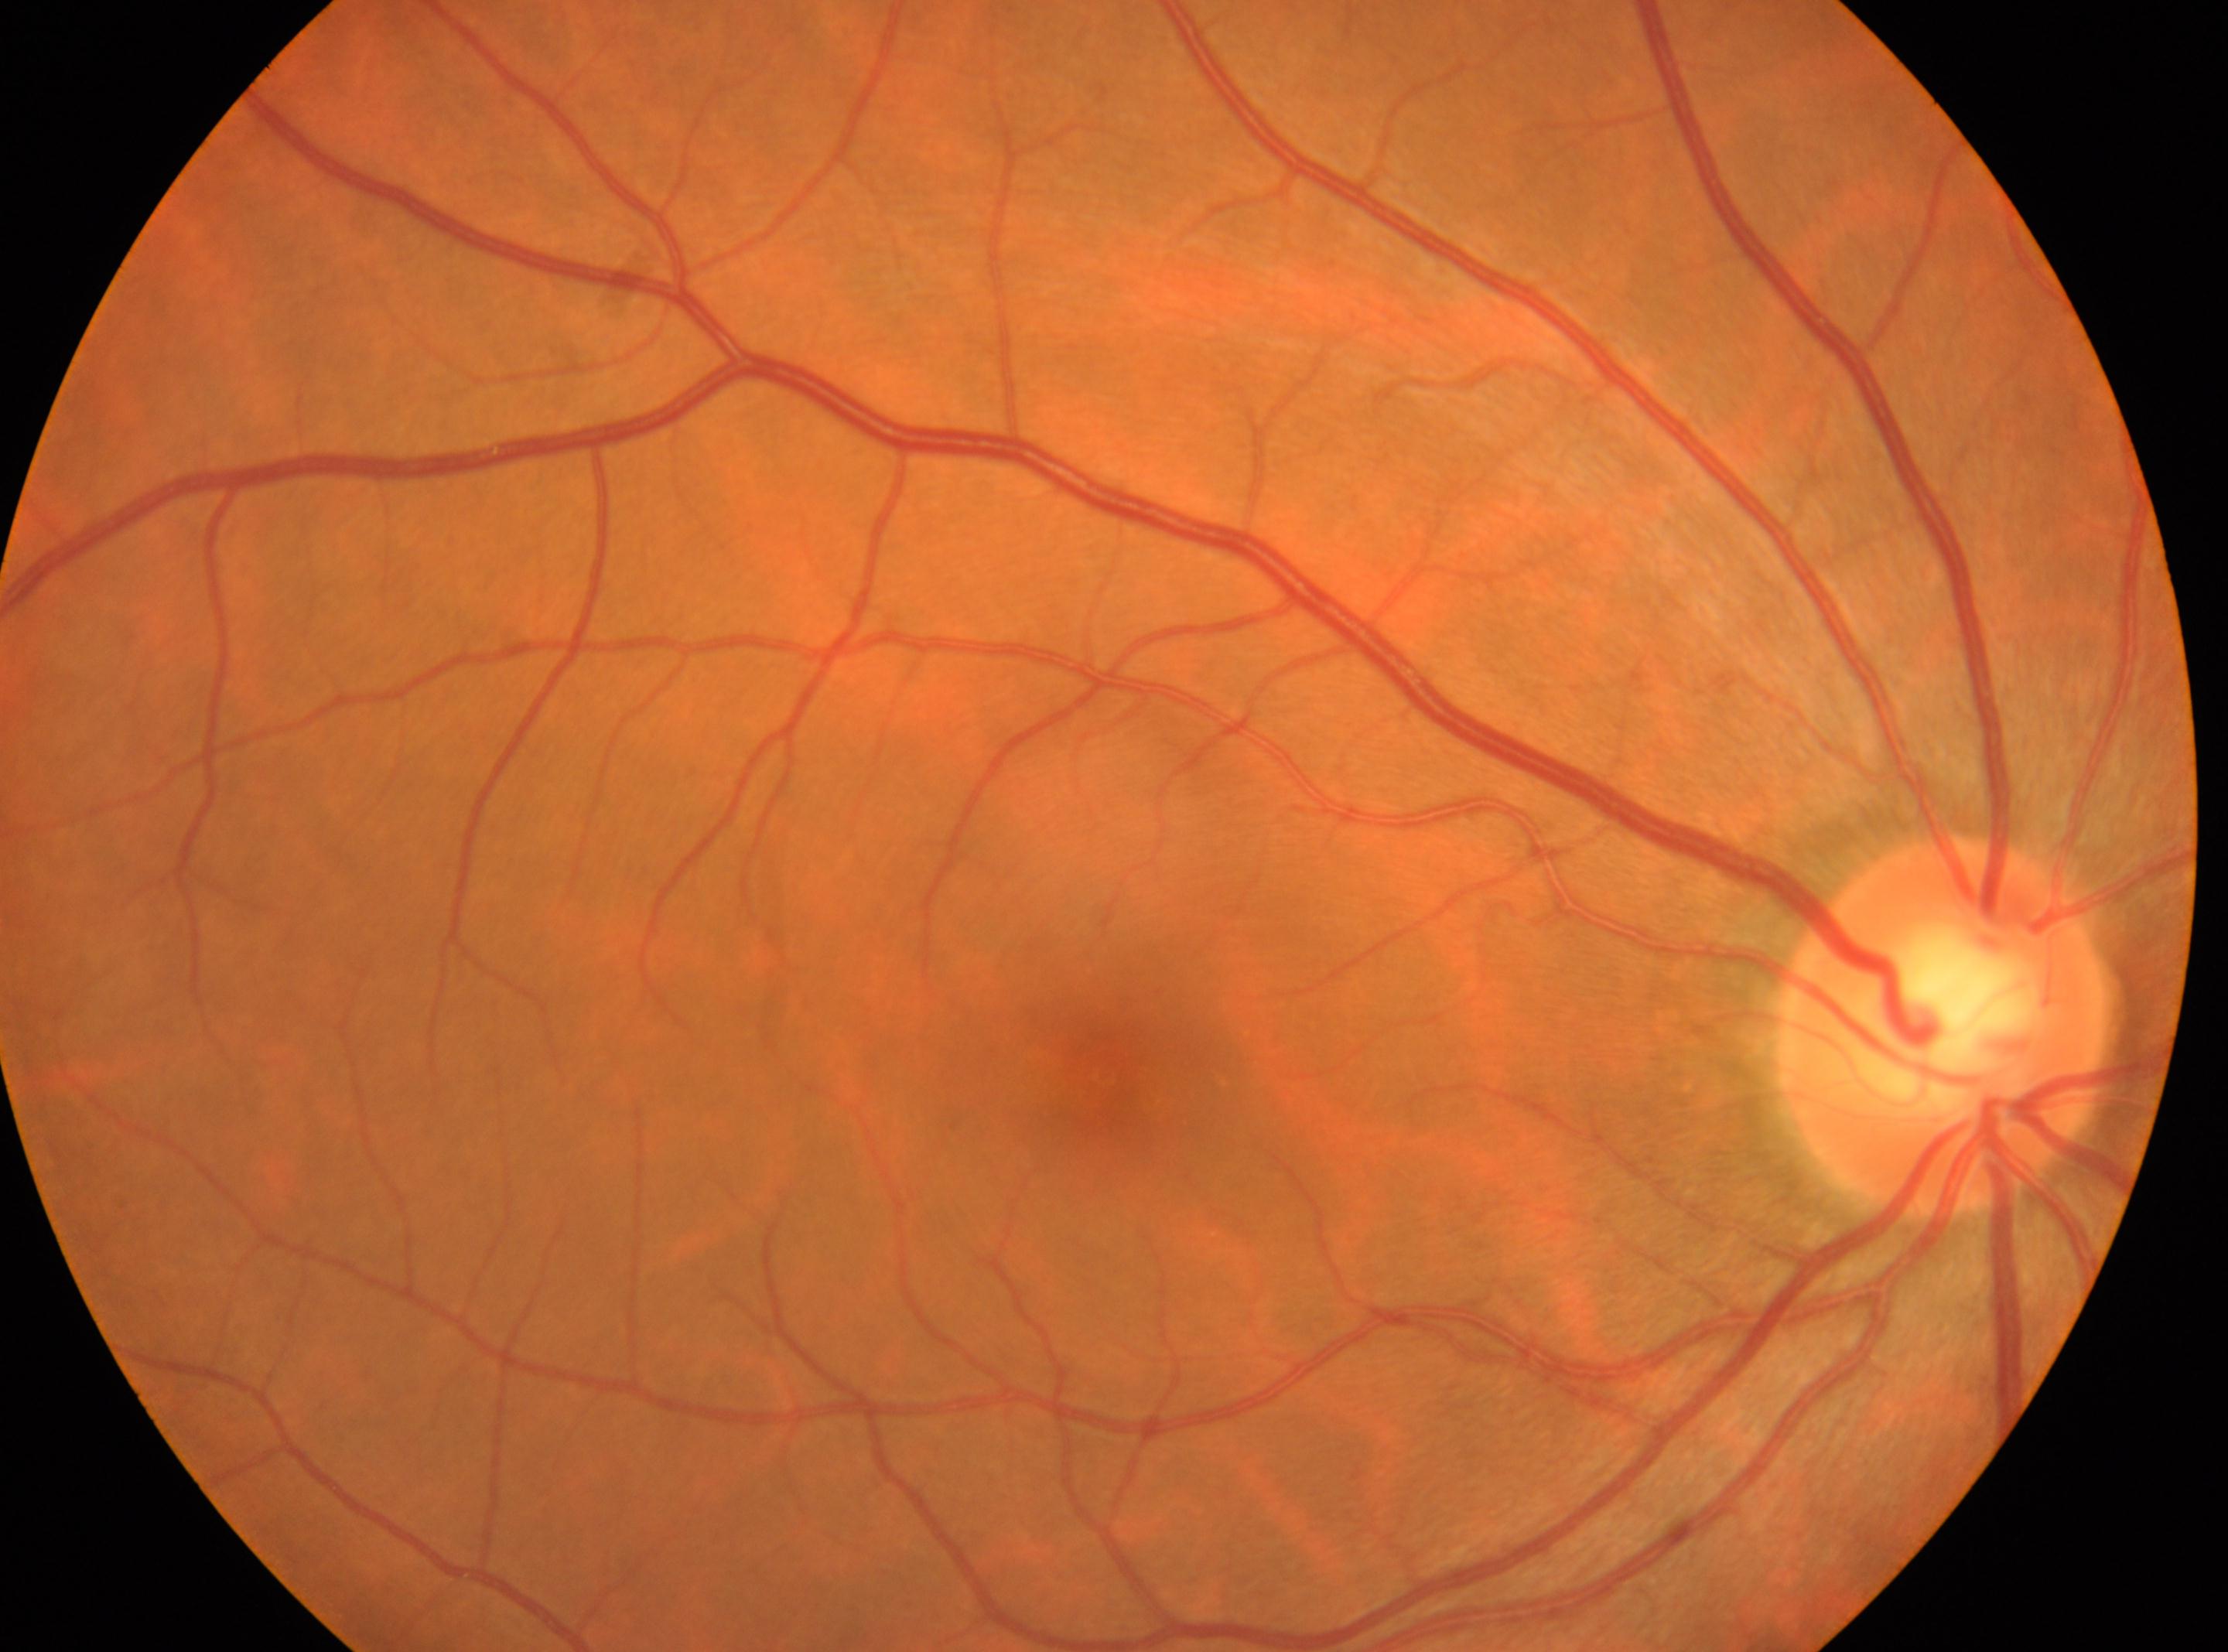
| key | value |
|---|---|
| optic disk | (1942, 1024) |
| diabetic retinopathy (DR) | grade 0 (no apparent retinopathy) — no visible signs of diabetic retinopathy |
| fovea centralis | (1103, 1078) |
| laterality | the right eye |